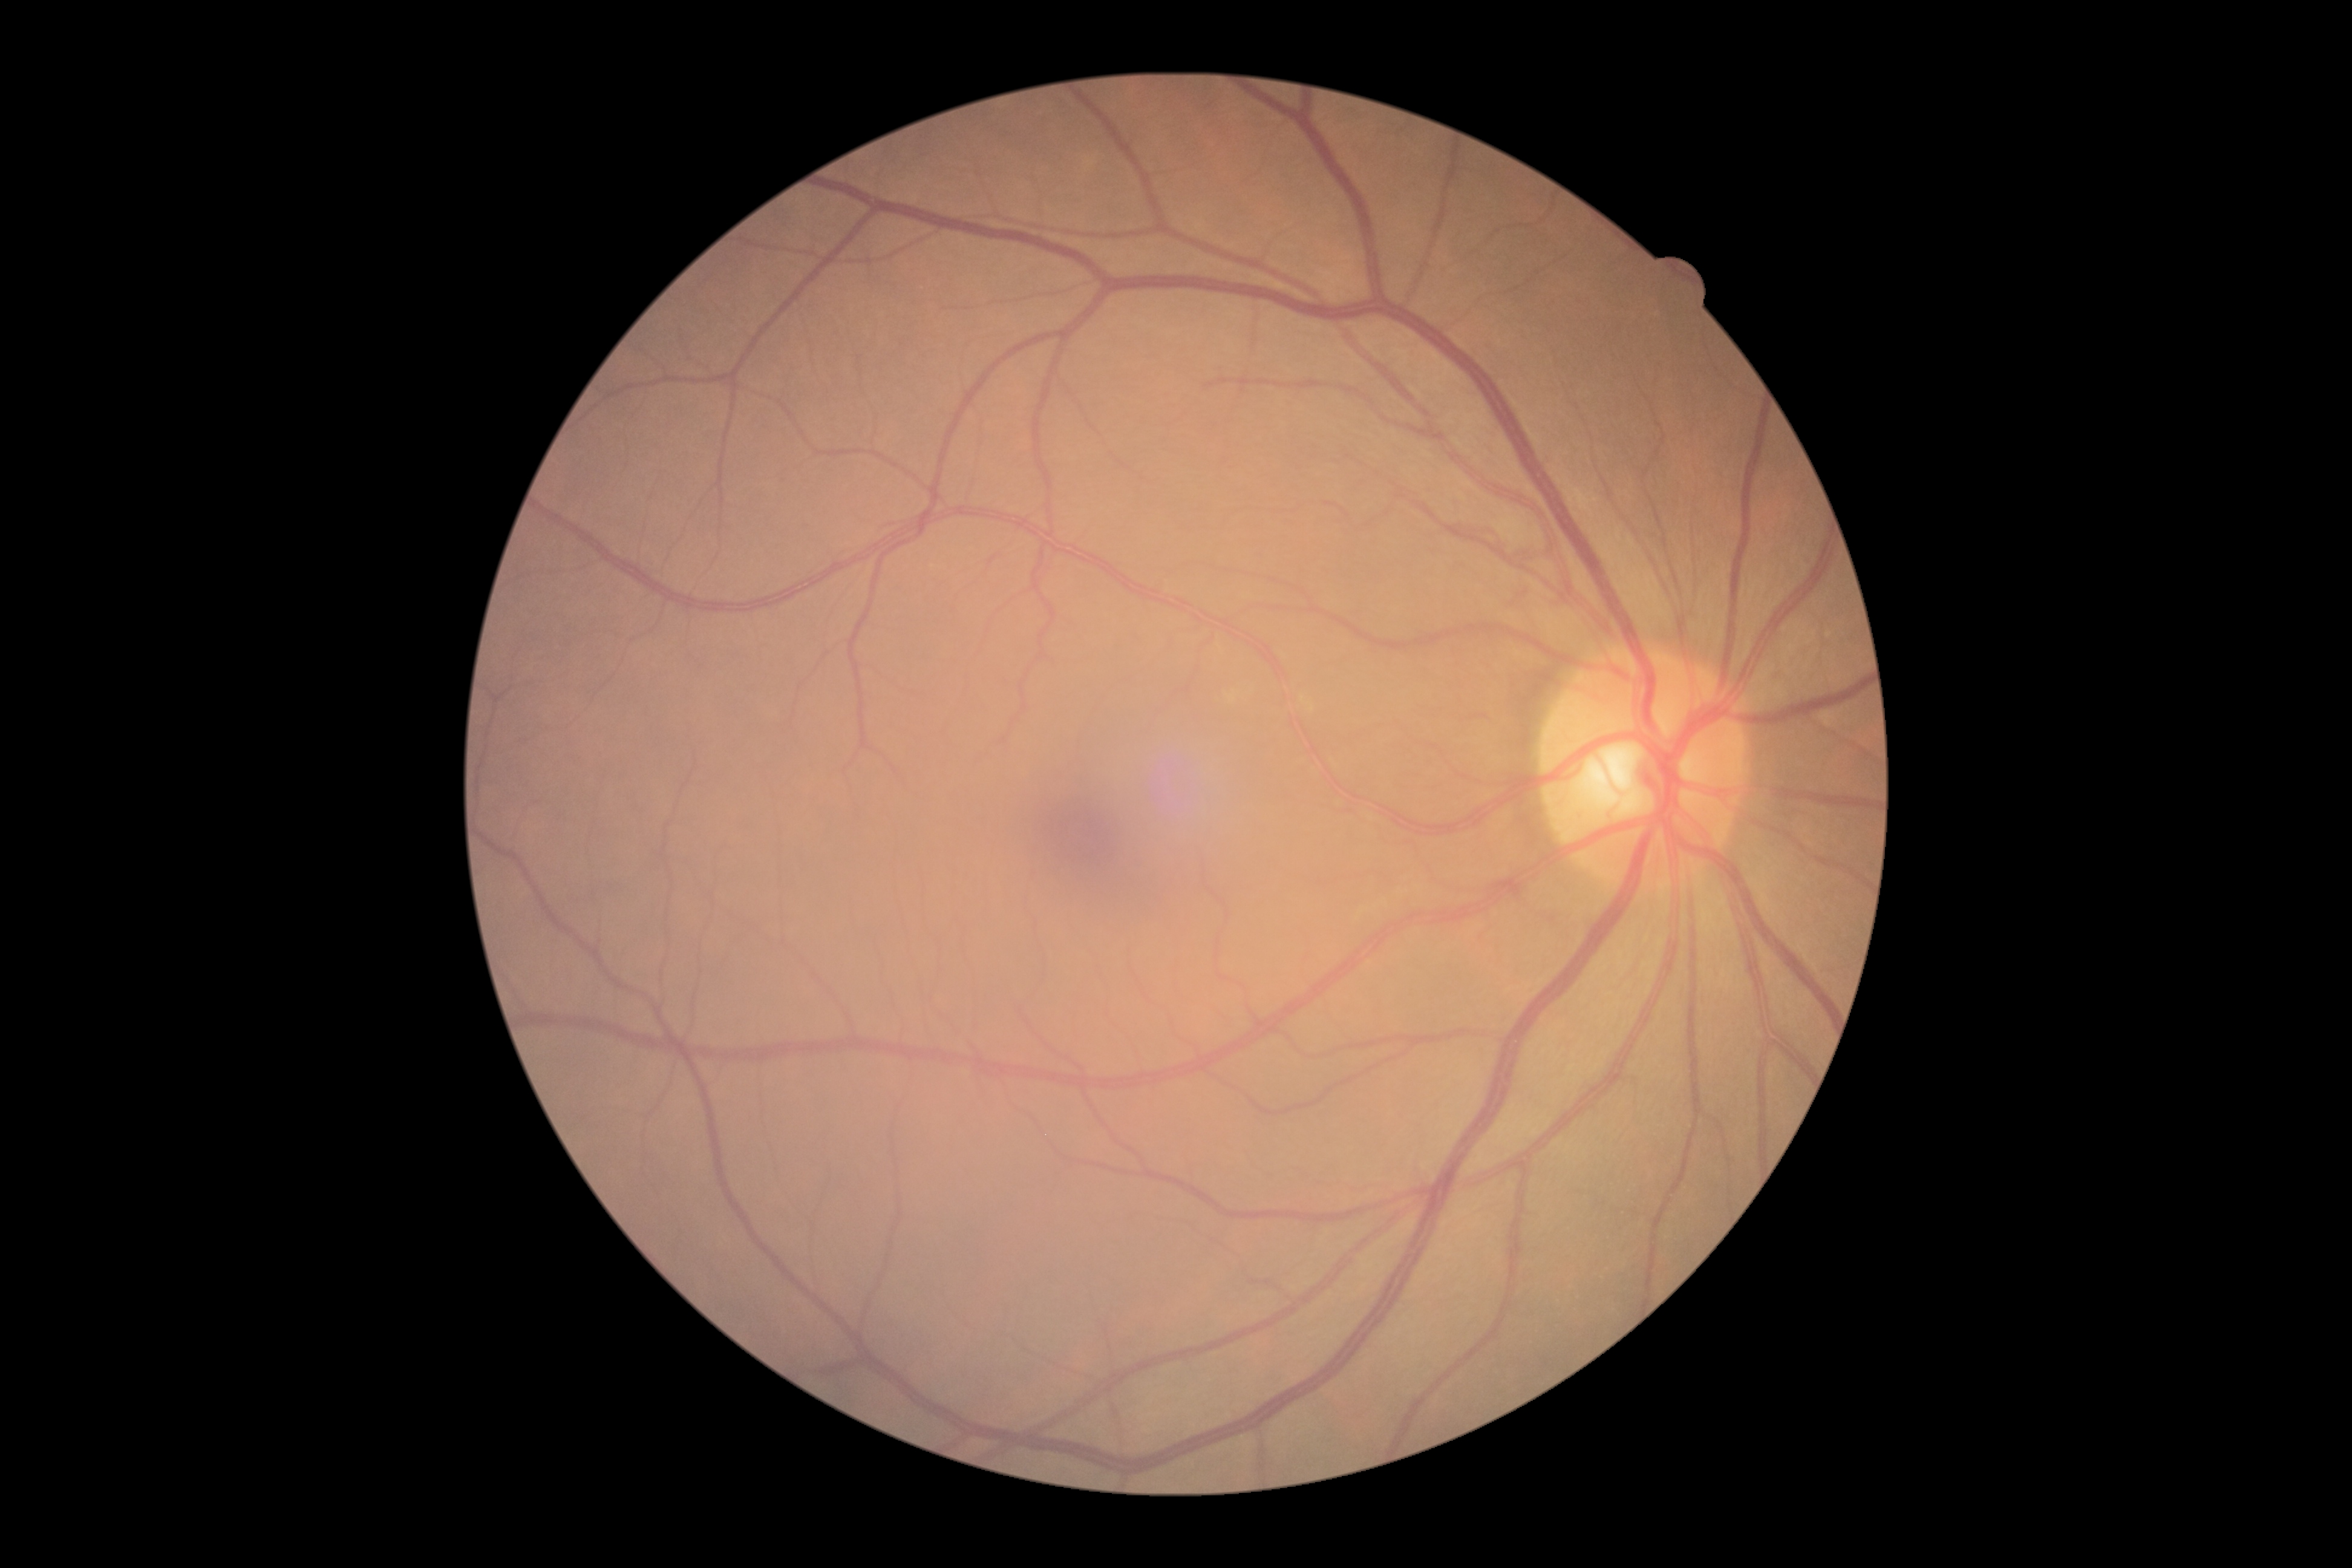

Diabetic retinopathy grade: 0 (no apparent retinopathy).